Retinal fundus photograph · nonmydriatic fundus photograph — 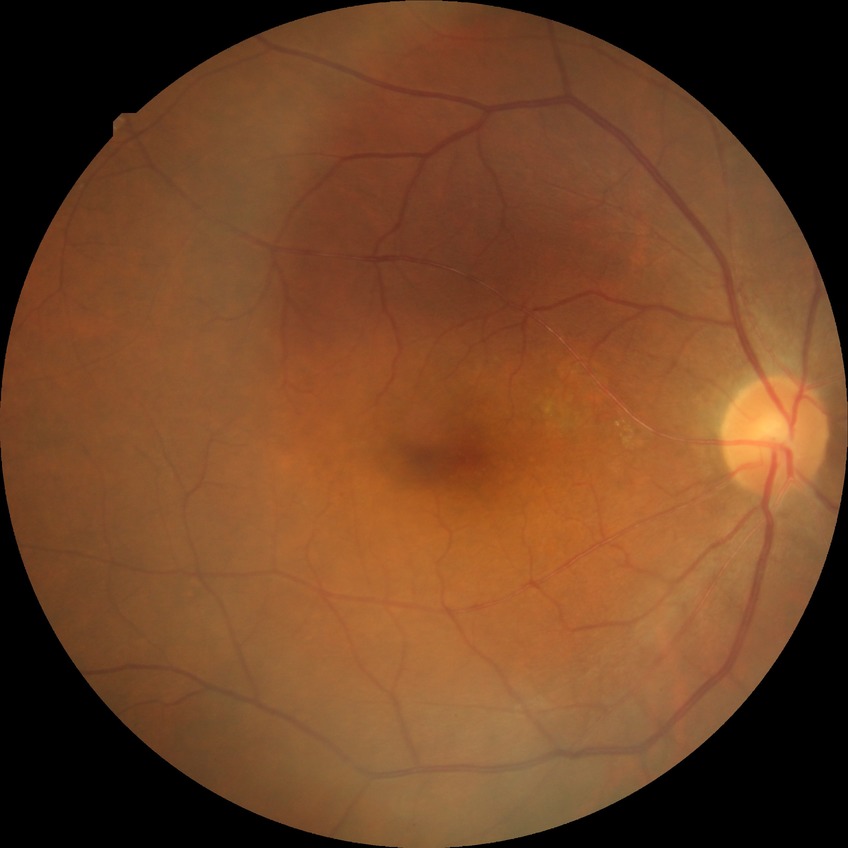

Davis stage is NDR.